240x240px, captured on a Nidek AFC-330 fundus camera
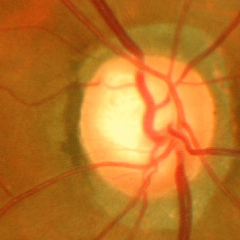

Diagnosis = advanced glaucomatous optic neuropathy. (Criteria: near-total cupping of the optic nerve head, with or without severe visual field loss within the central 10 degrees of fixation.)